848 by 848 pixels — 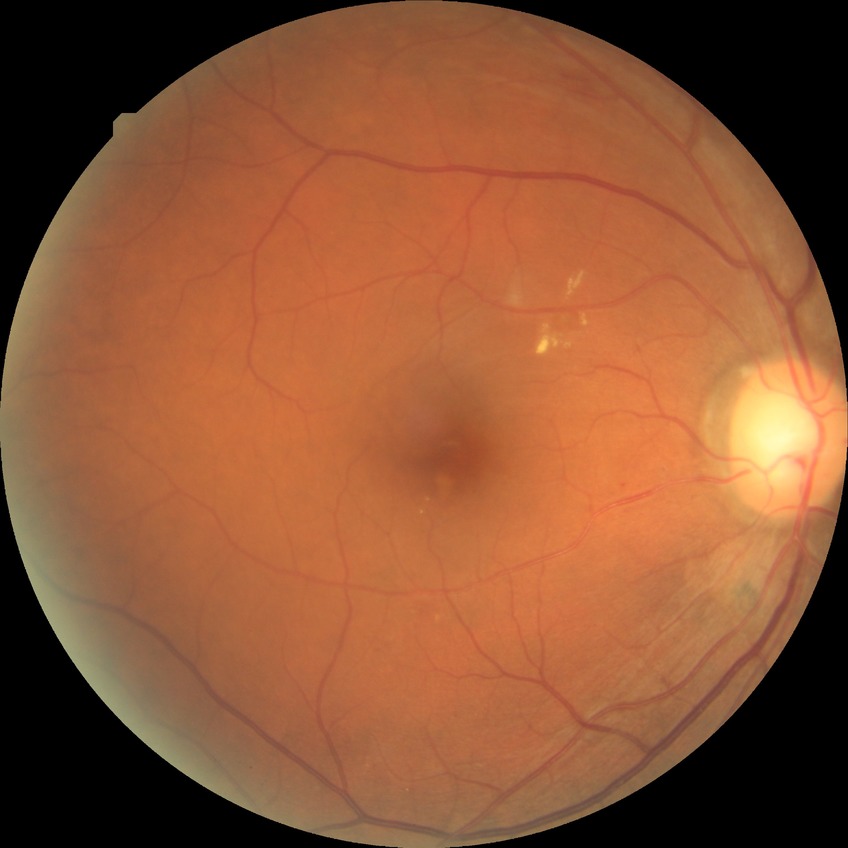

DR class: non-proliferative diabetic retinopathy
diabetic retinopathy (DR): simple diabetic retinopathy (SDR)